Nonmydriatic · retinal fundus photograph:
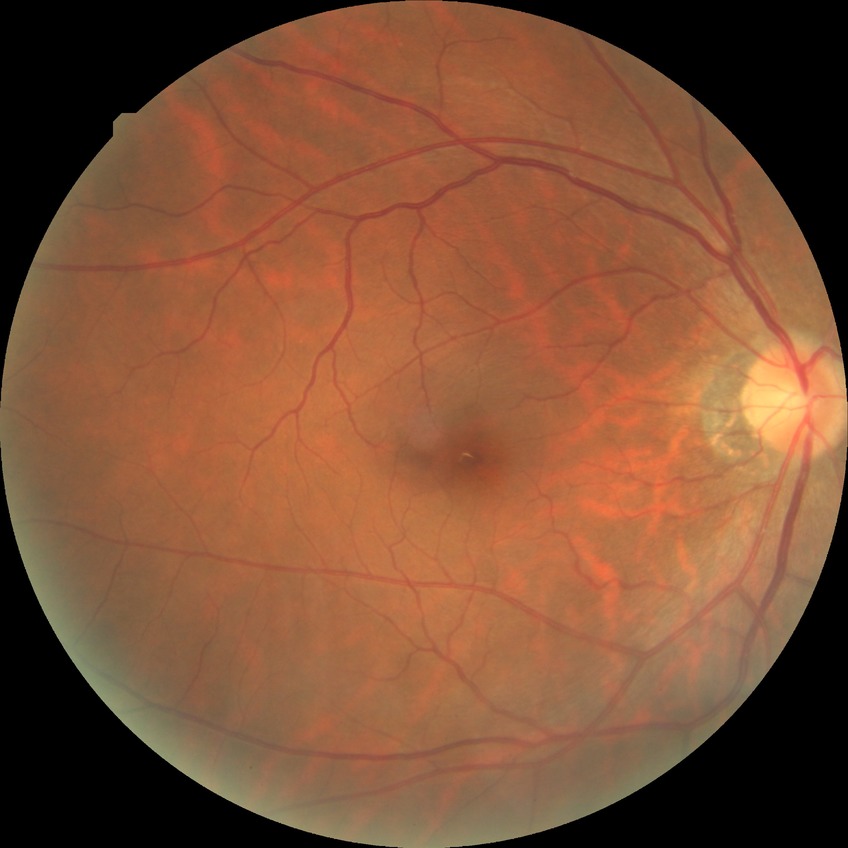
Diabetic retinopathy (DR) is no diabetic retinopathy (NDR).